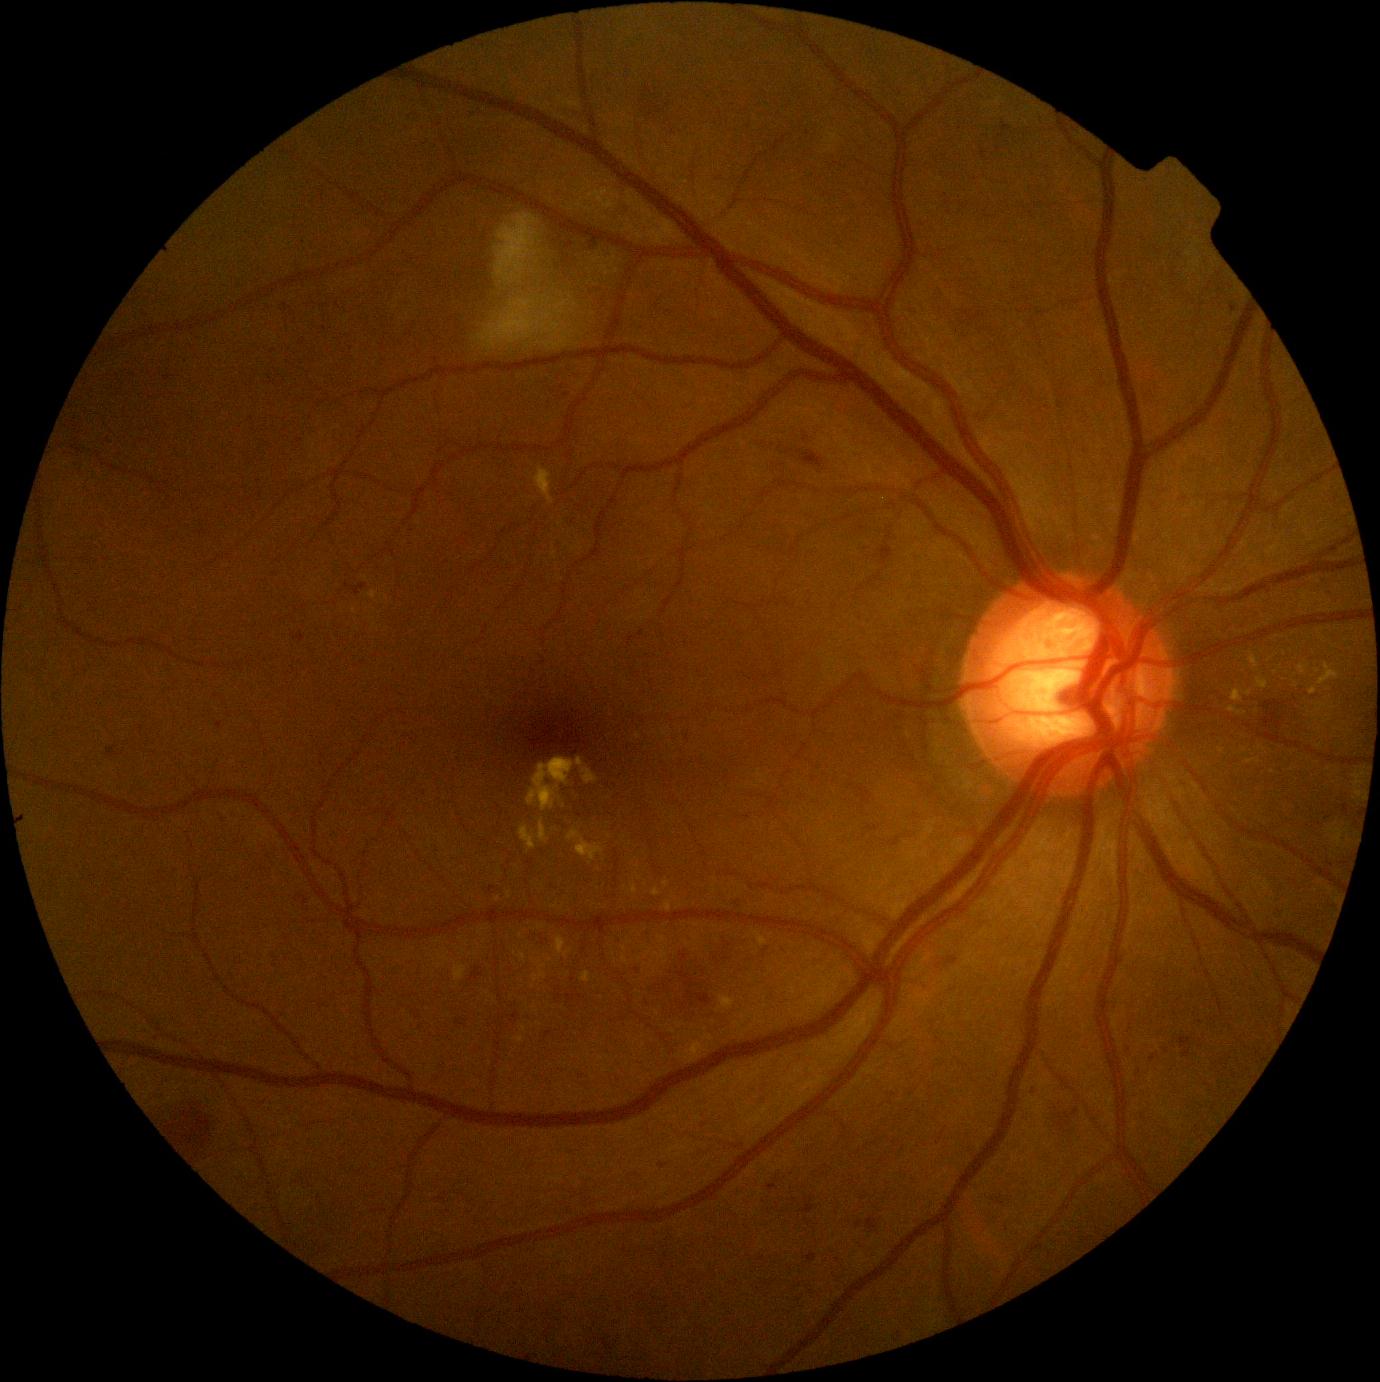 Retinopathy: moderate non-proliferative diabetic retinopathy (grade 2). Hard exudates include those at [534,965,547,982]; [1310,688,1318,696]; [630,884,639,895]; [519,953,525,962]; [567,830,605,861]; [555,936,573,958]; [539,819,550,842]; [538,926,546,930]; [368,591,377,600]; [507,891,512,899]; [1256,678,1268,689]. Smaller hard exudates around (1245, 713); (366, 578); (525, 1029); (1262, 749); (374, 625). Microaneurysms include those at [1343,805,1349,815]; [456,1018,466,1027]; [1034,1087,1042,1094]; [804,1253,817,1263]; [294,633,306,642]; [345,583,368,596]; [997,1197,1005,1206]; [1179,1037,1193,1049]; [1072,1109,1080,1117]. Smaller microaneurysms around (641, 634); (1153, 1059); (688, 738); (860, 1225); (1167, 1051).